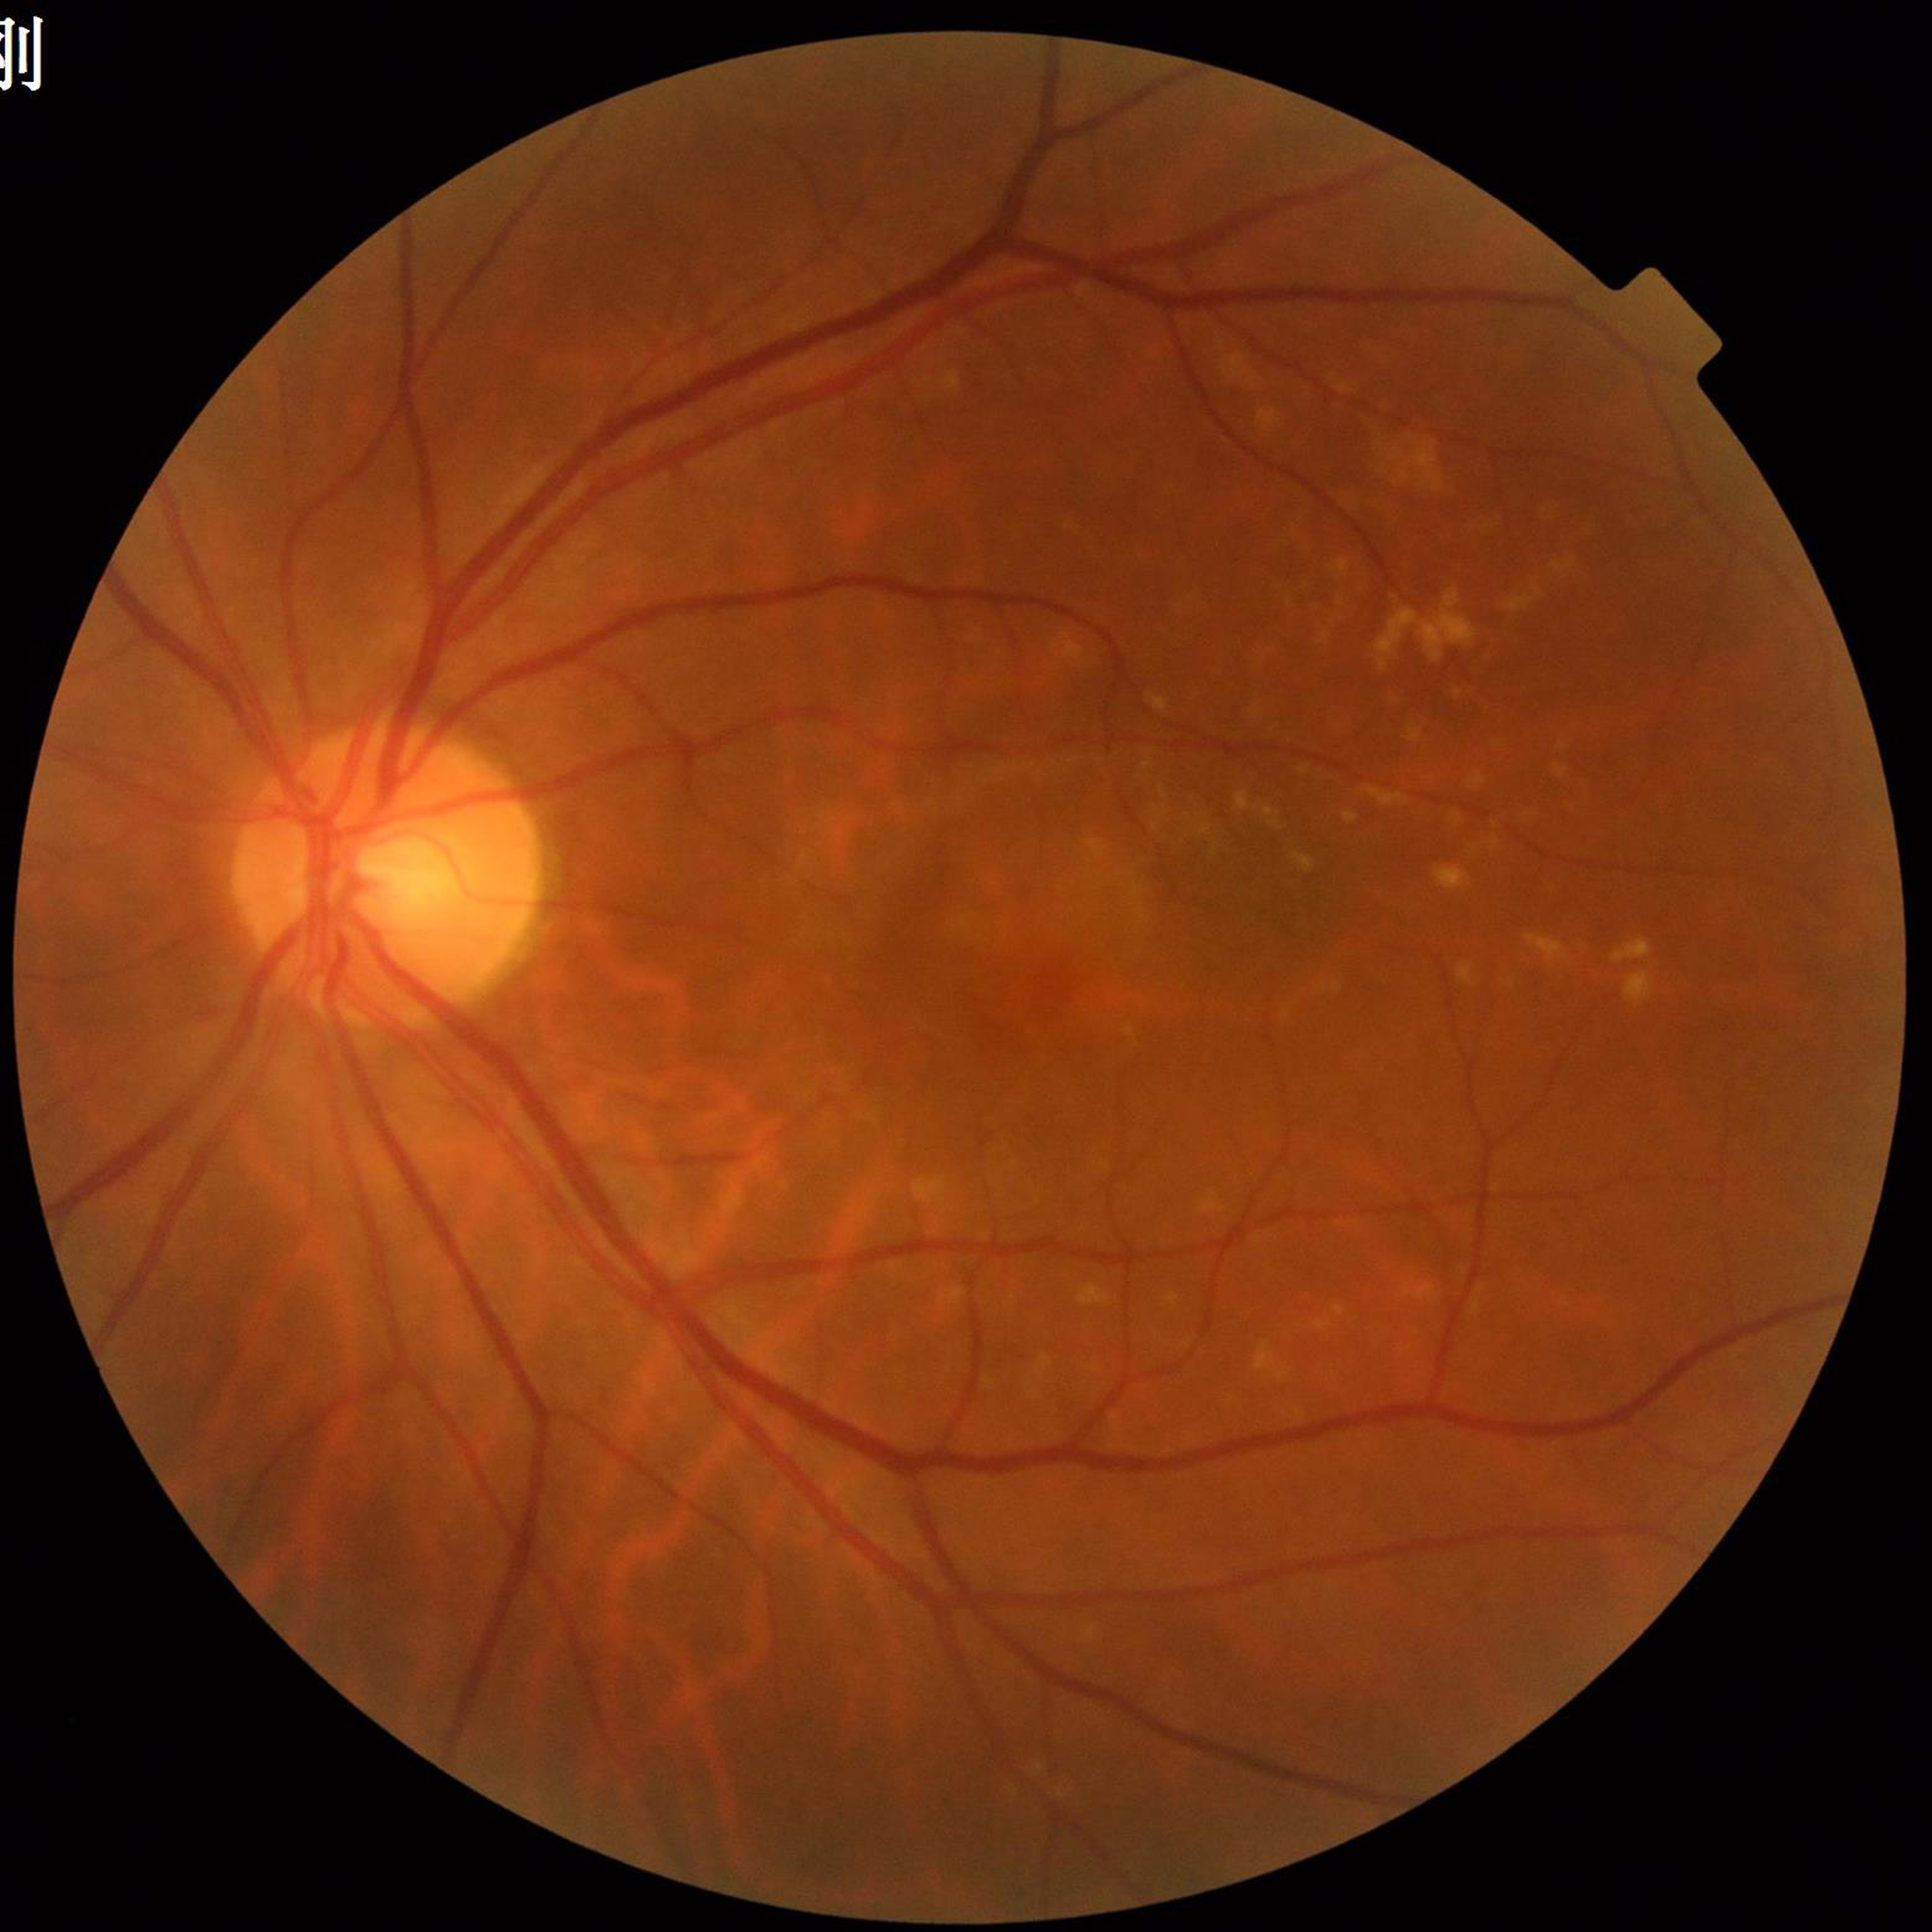
Fundus image of an eye with age-related macular degeneration.